Fundus photo, 2212x1659px
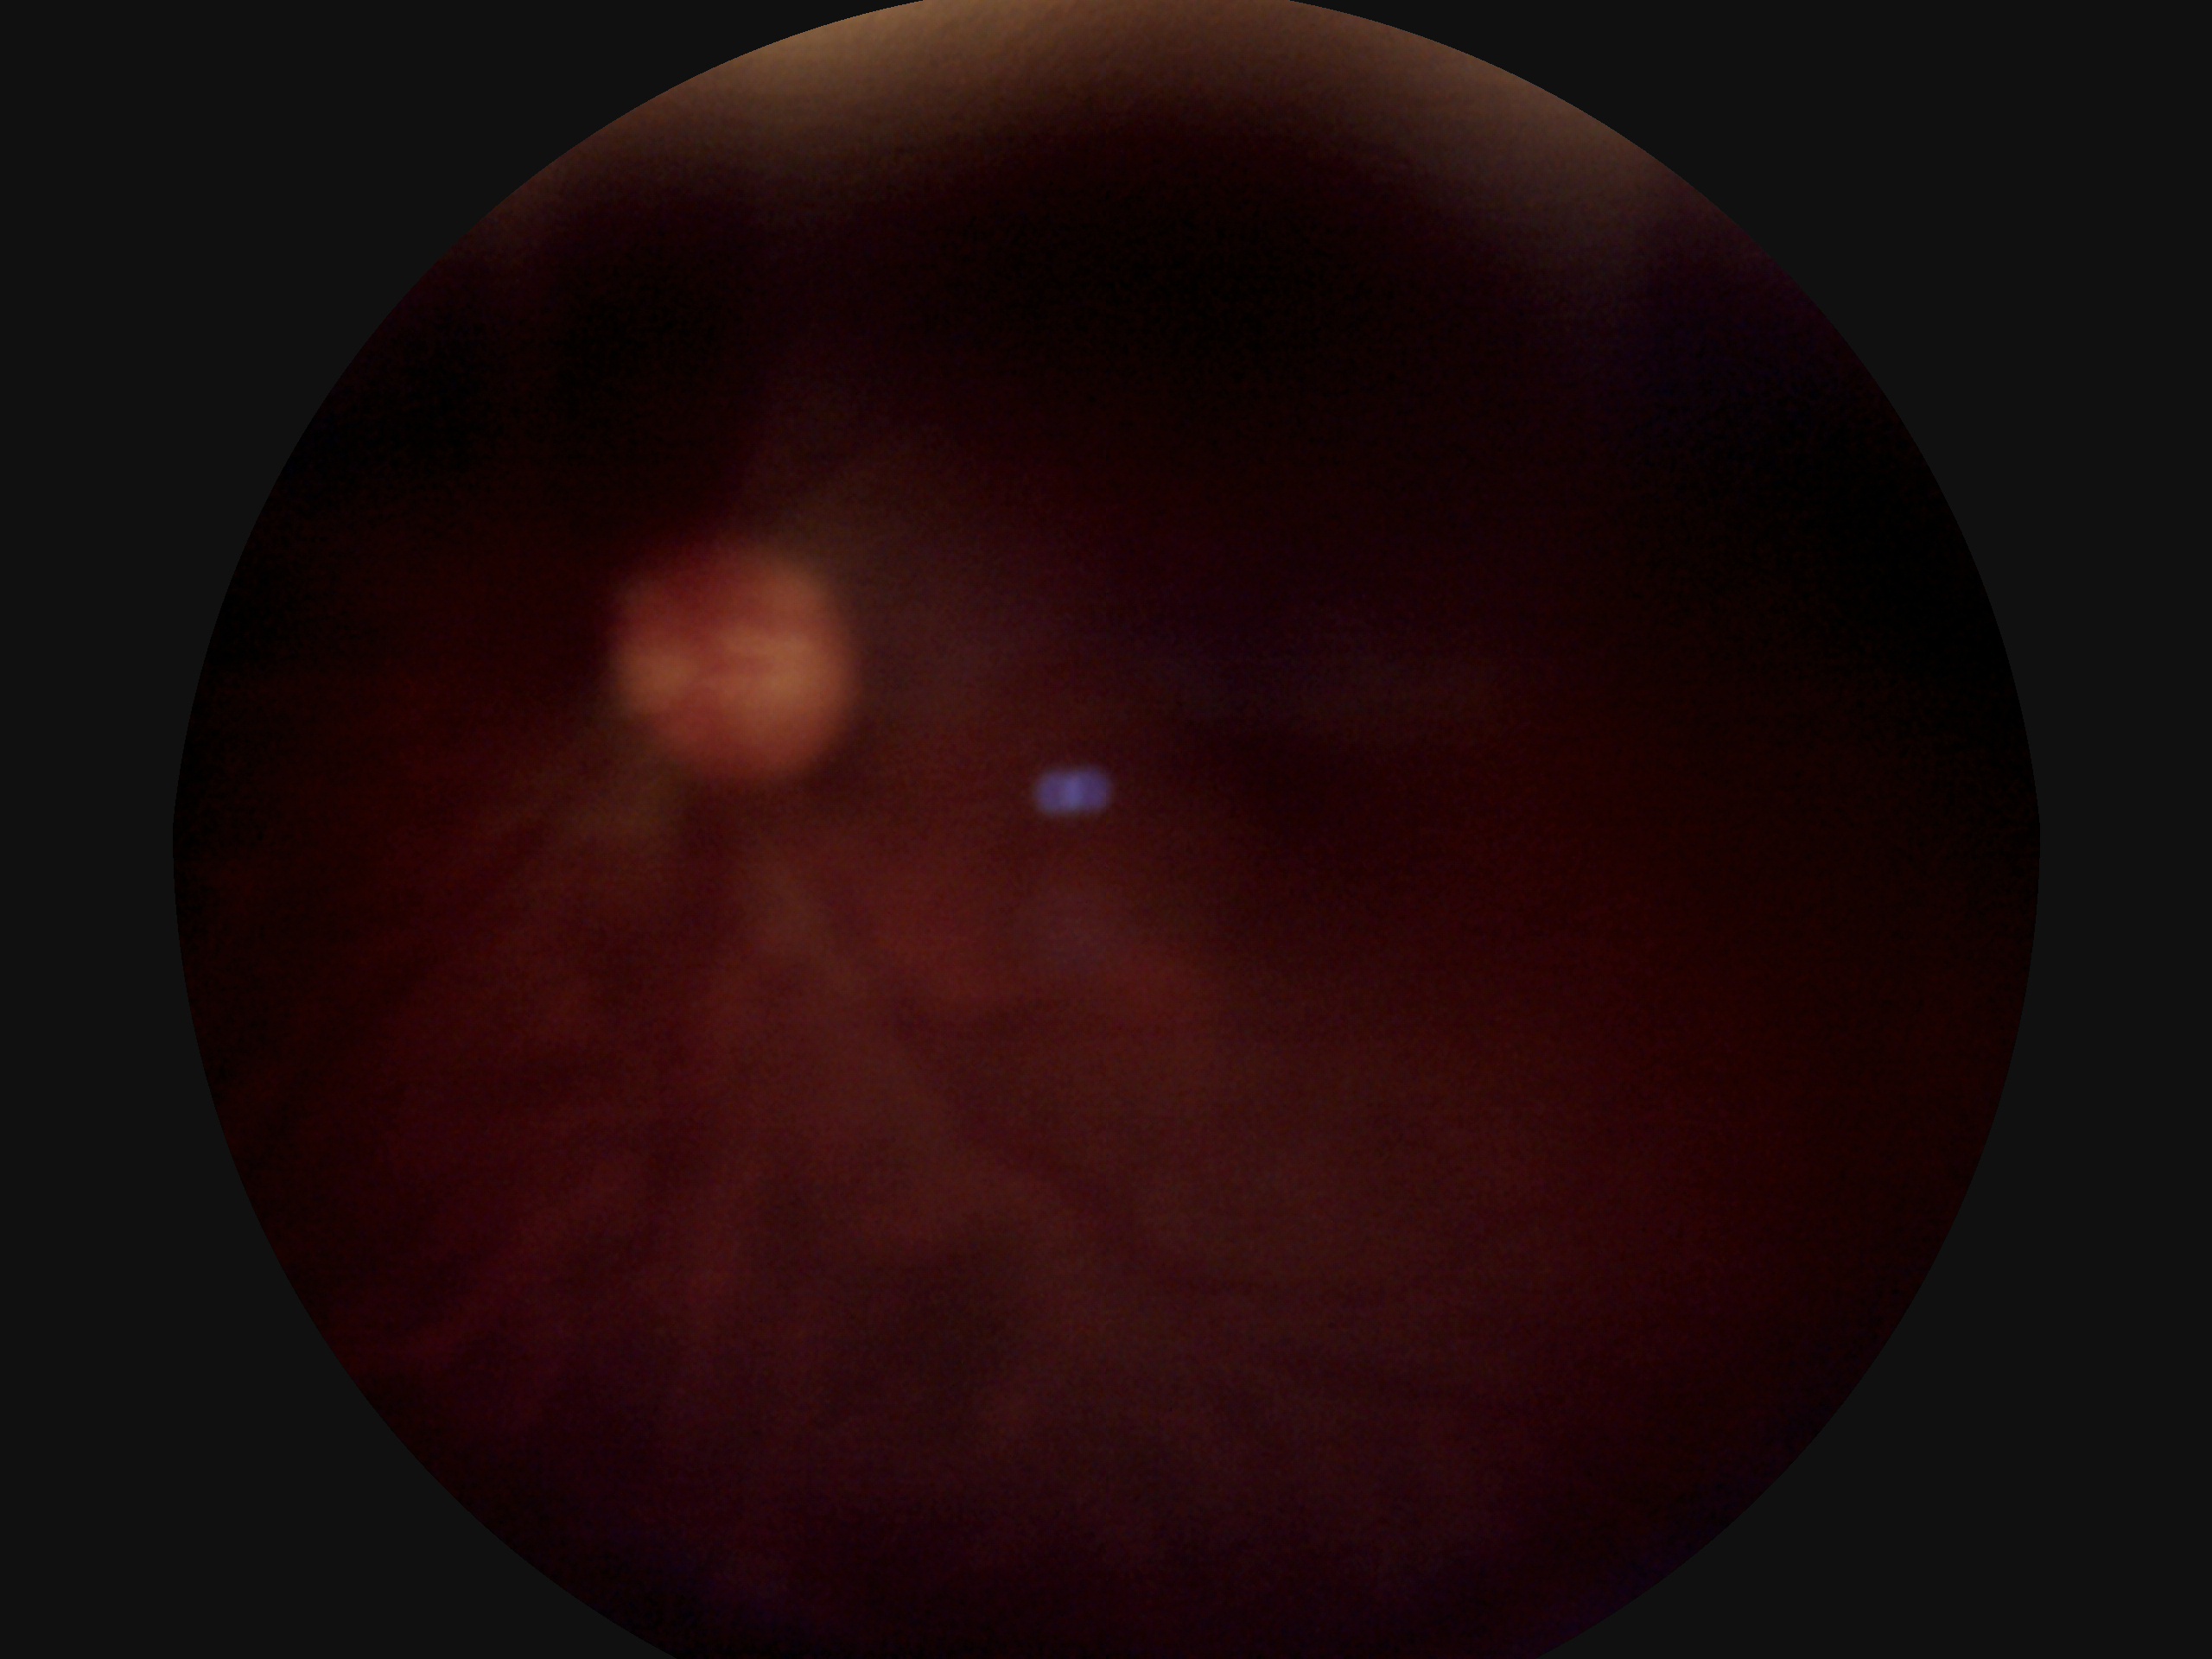

diabetic retinopathy grade@ungradable due to poor image quality; image quality@below grading threshold.